Wide-field contact fundus photograph of an infant. Clarity RetCam 3, 130° FOV. 640x480px: 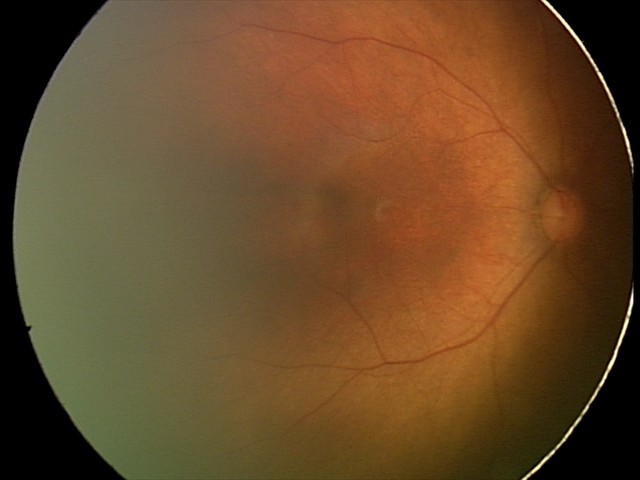 No retinal pathology identified on screening.